FOV: 45 degrees; posterior pole color fundus photograph; 848x848; camera: NIDEK AFC-230; nonmydriatic fundus photograph: 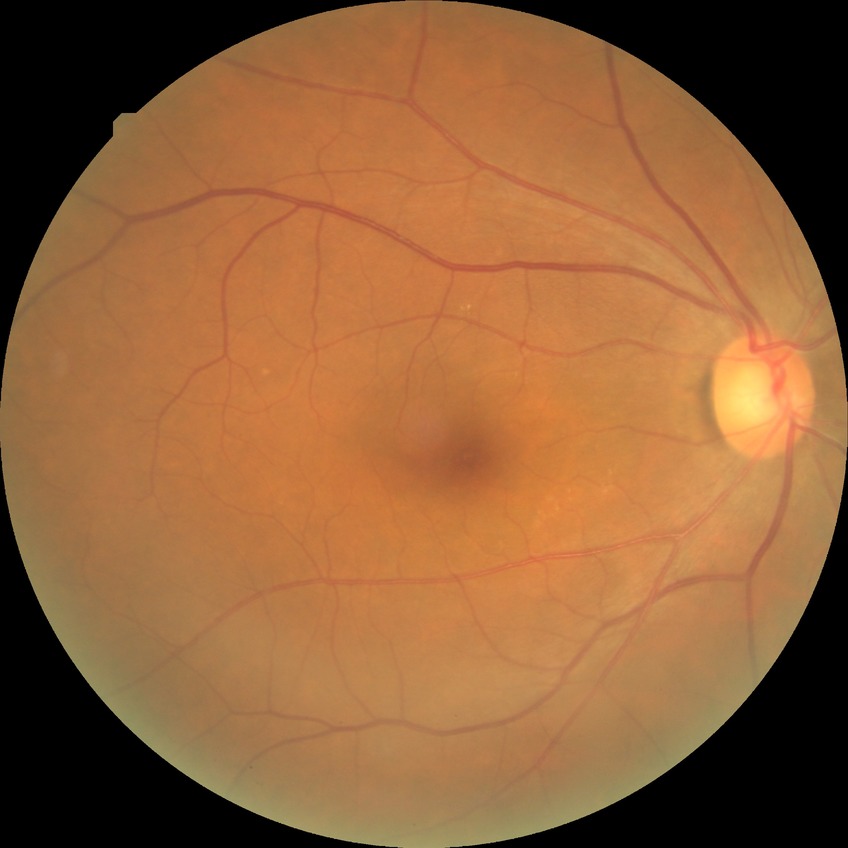
* retinopathy grade — no diabetic retinopathy